Ultra-widefield (UWF) fundus image:
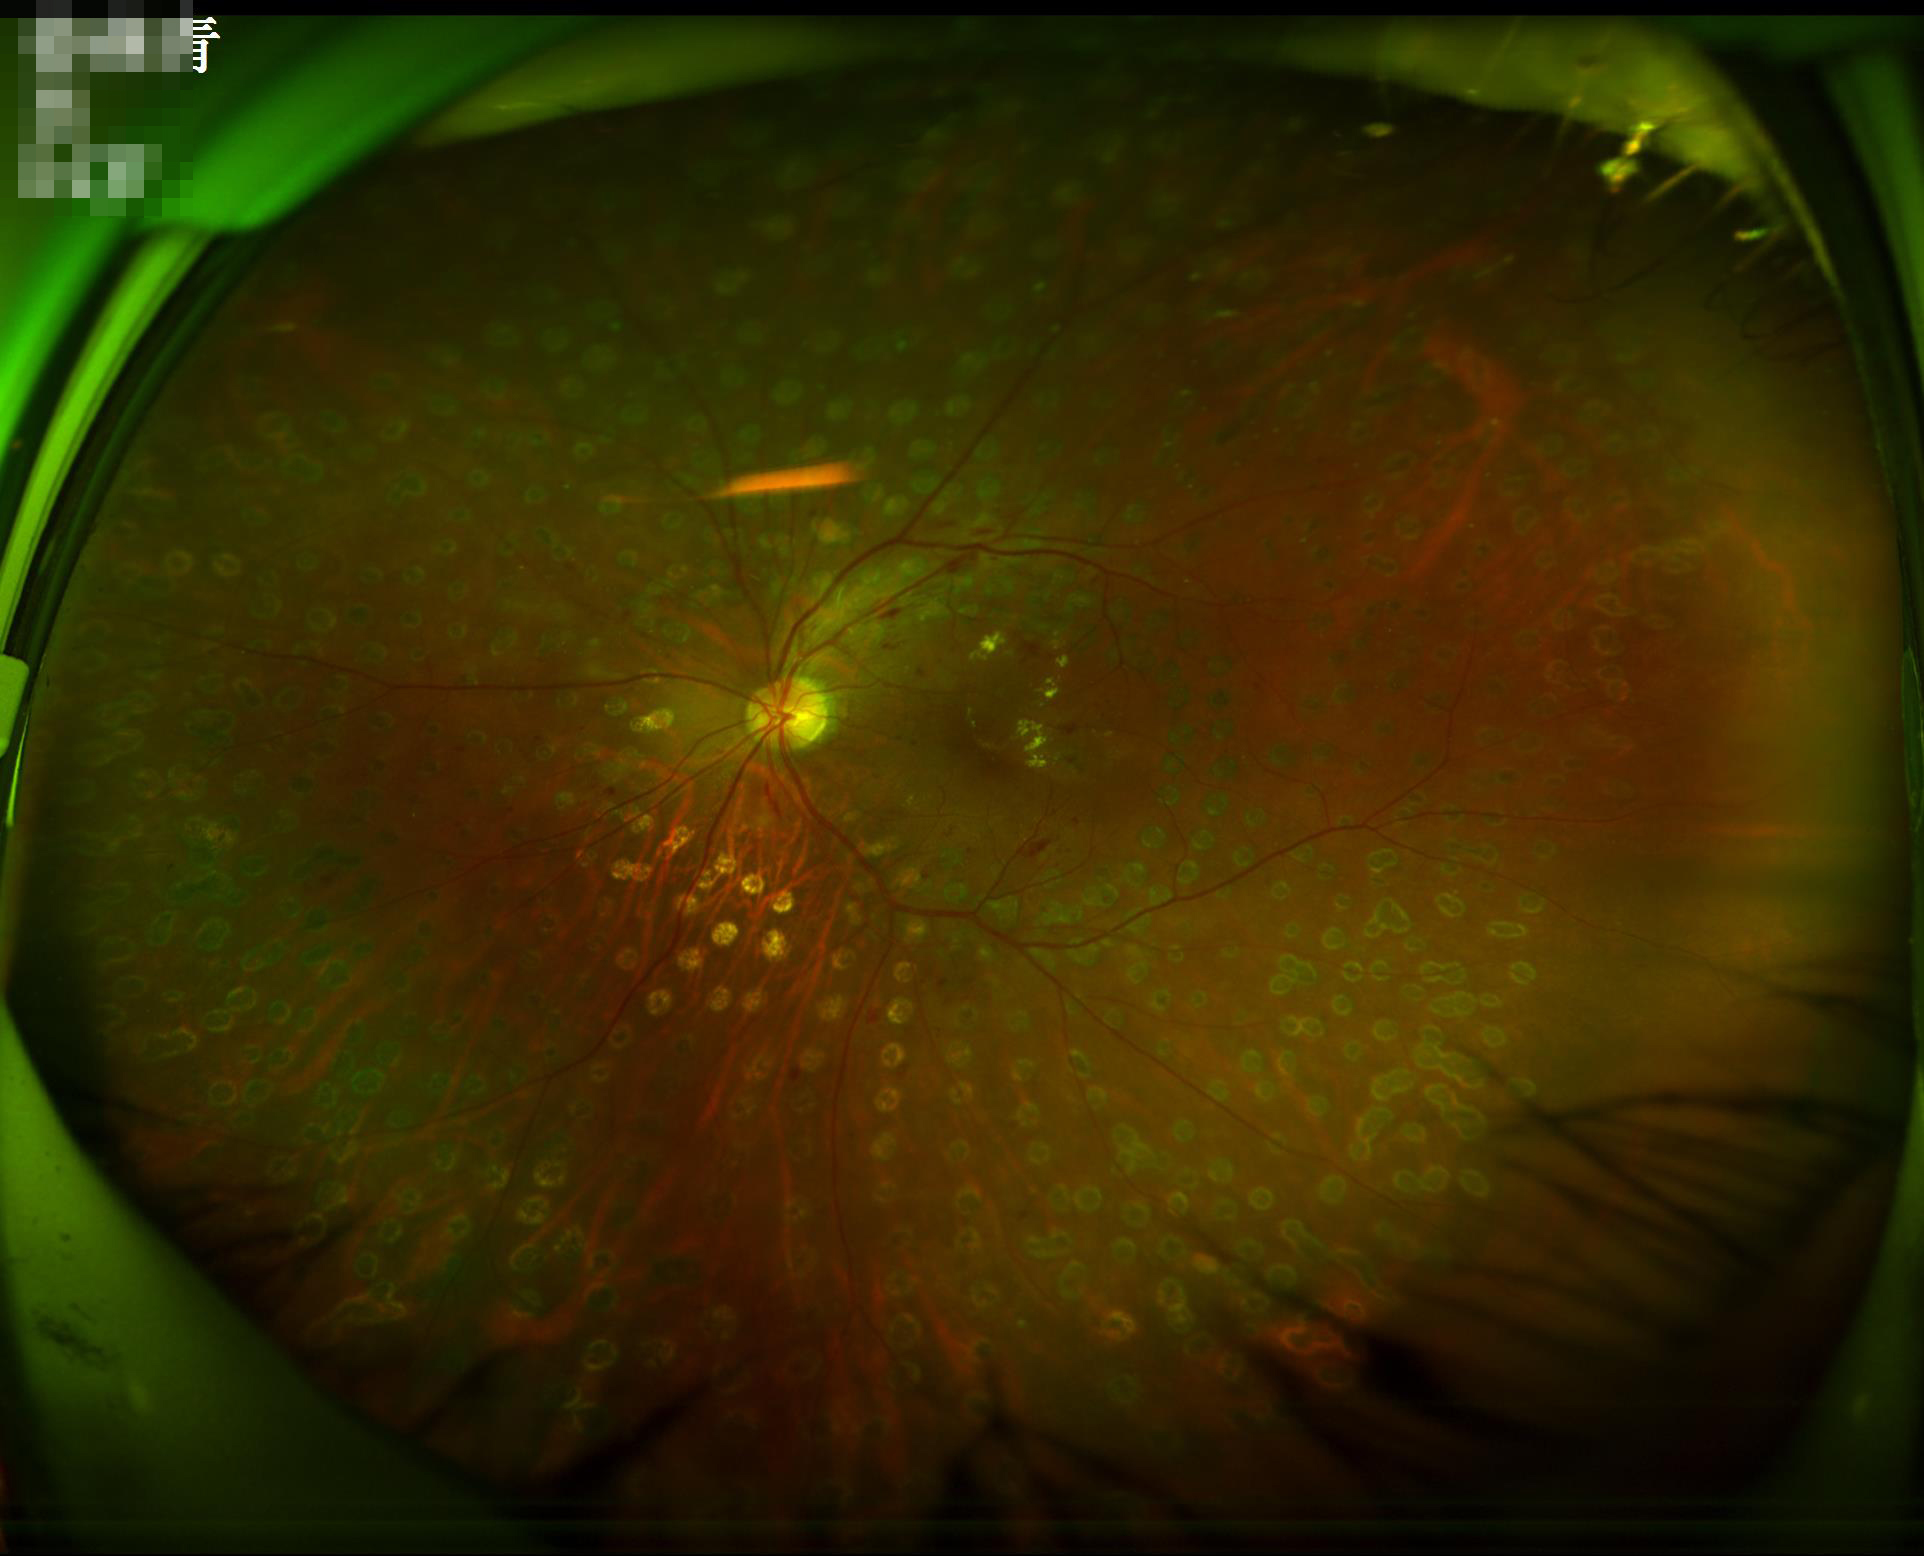 Image quality:
- illumination: inadequate, with uneven exposure or color distortion
- contrast: good dynamic range
- overall: adequate for clinical interpretation